1515x1275px.
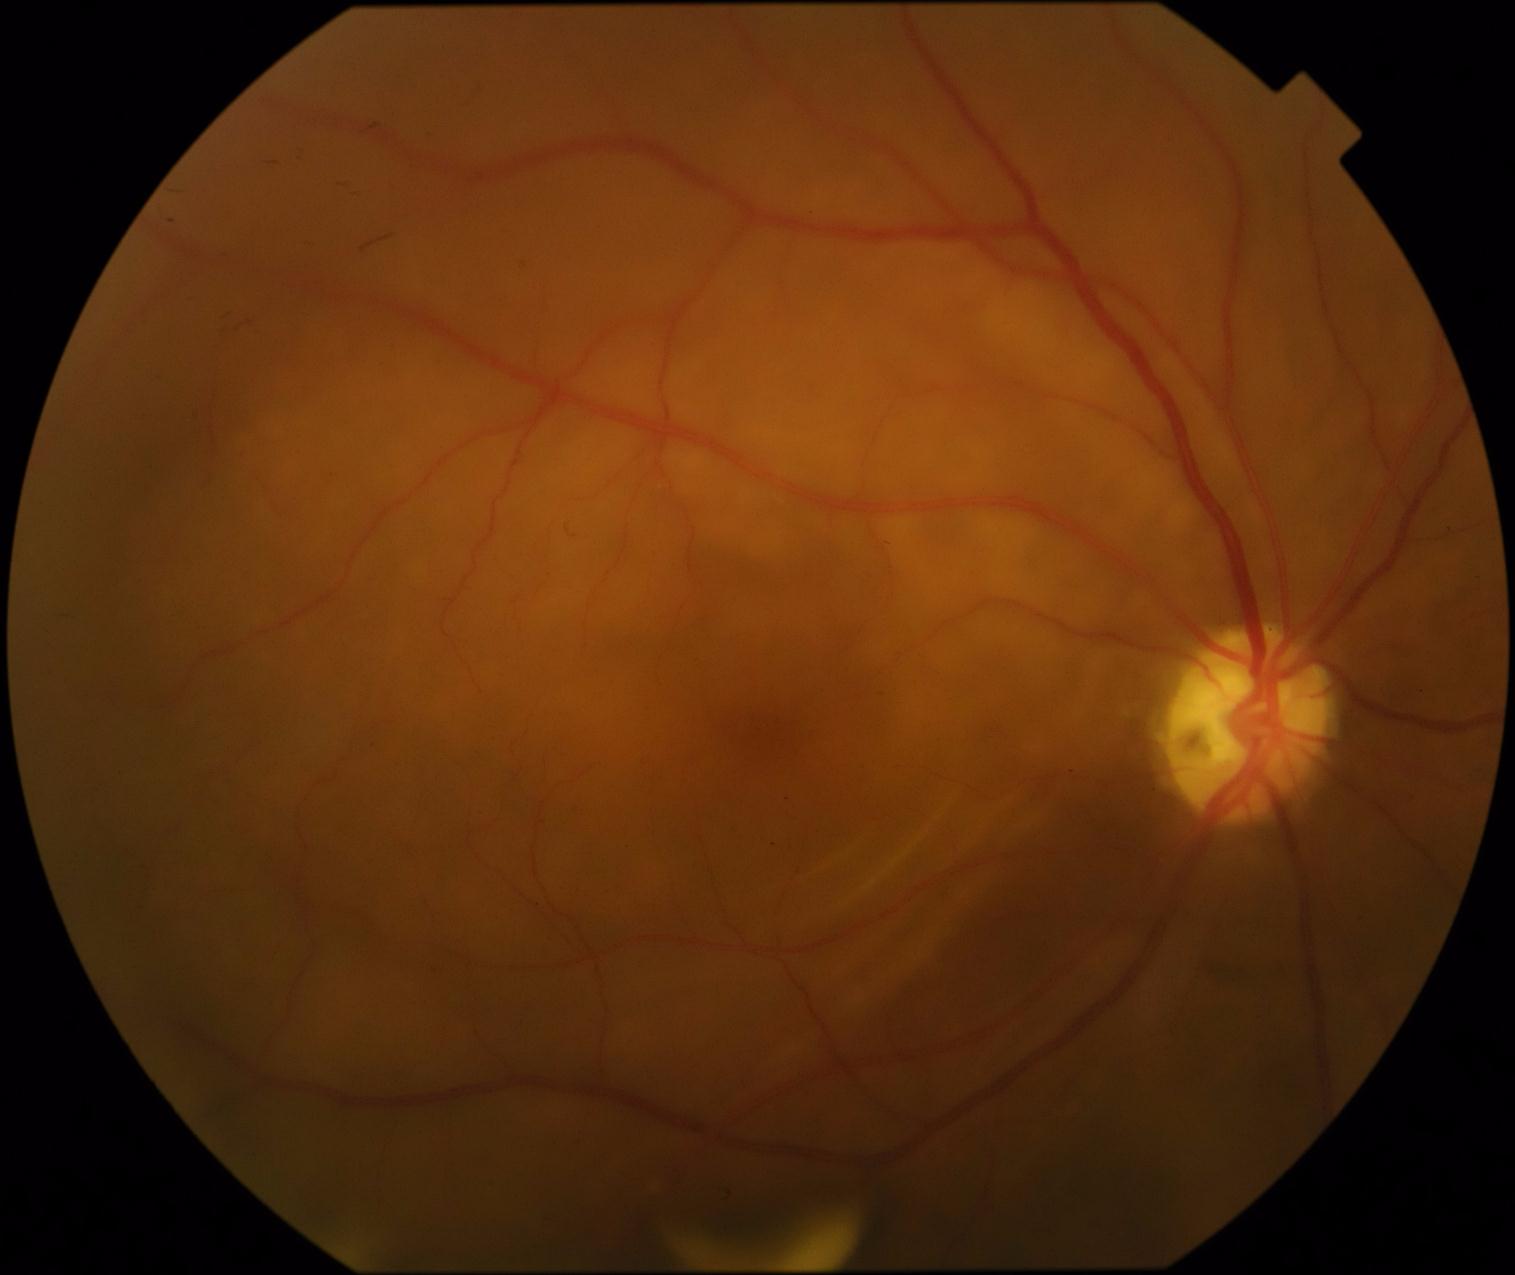

DR grade is proliferative diabetic retinopathy (4).